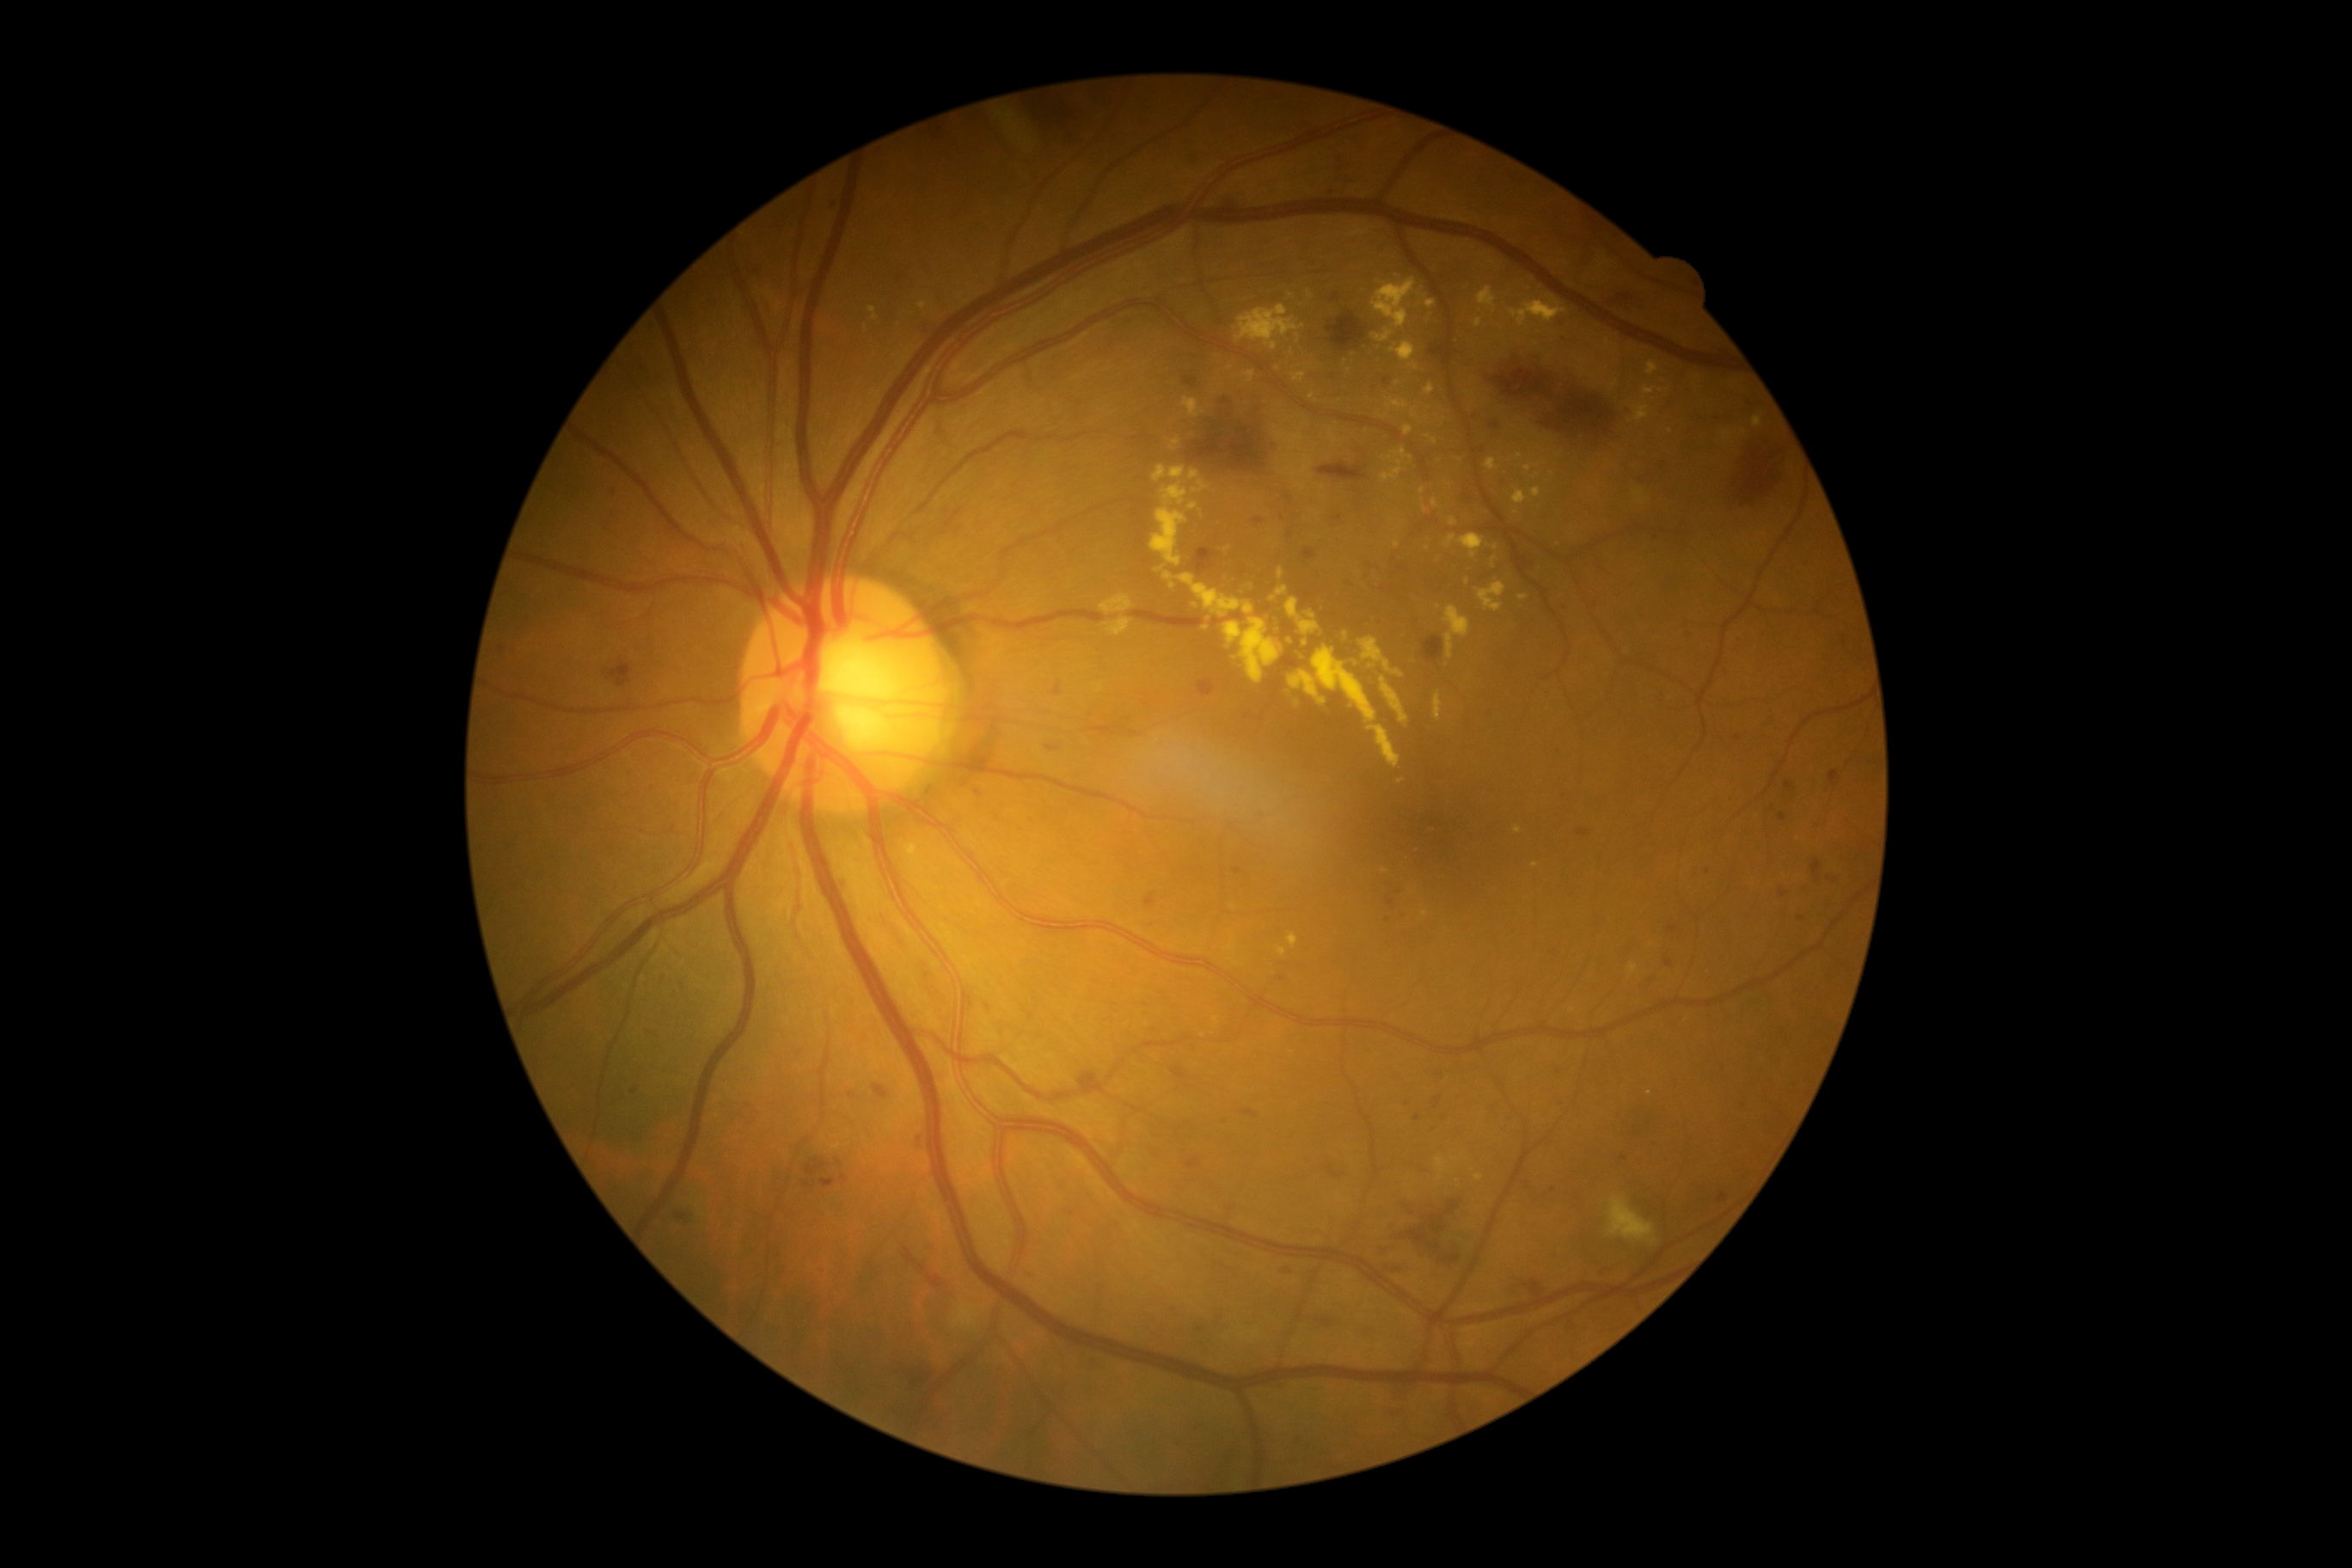 Diabetic retinopathy (DR): 2.